Infant wide-field fundus photograph · image size 1240x1240
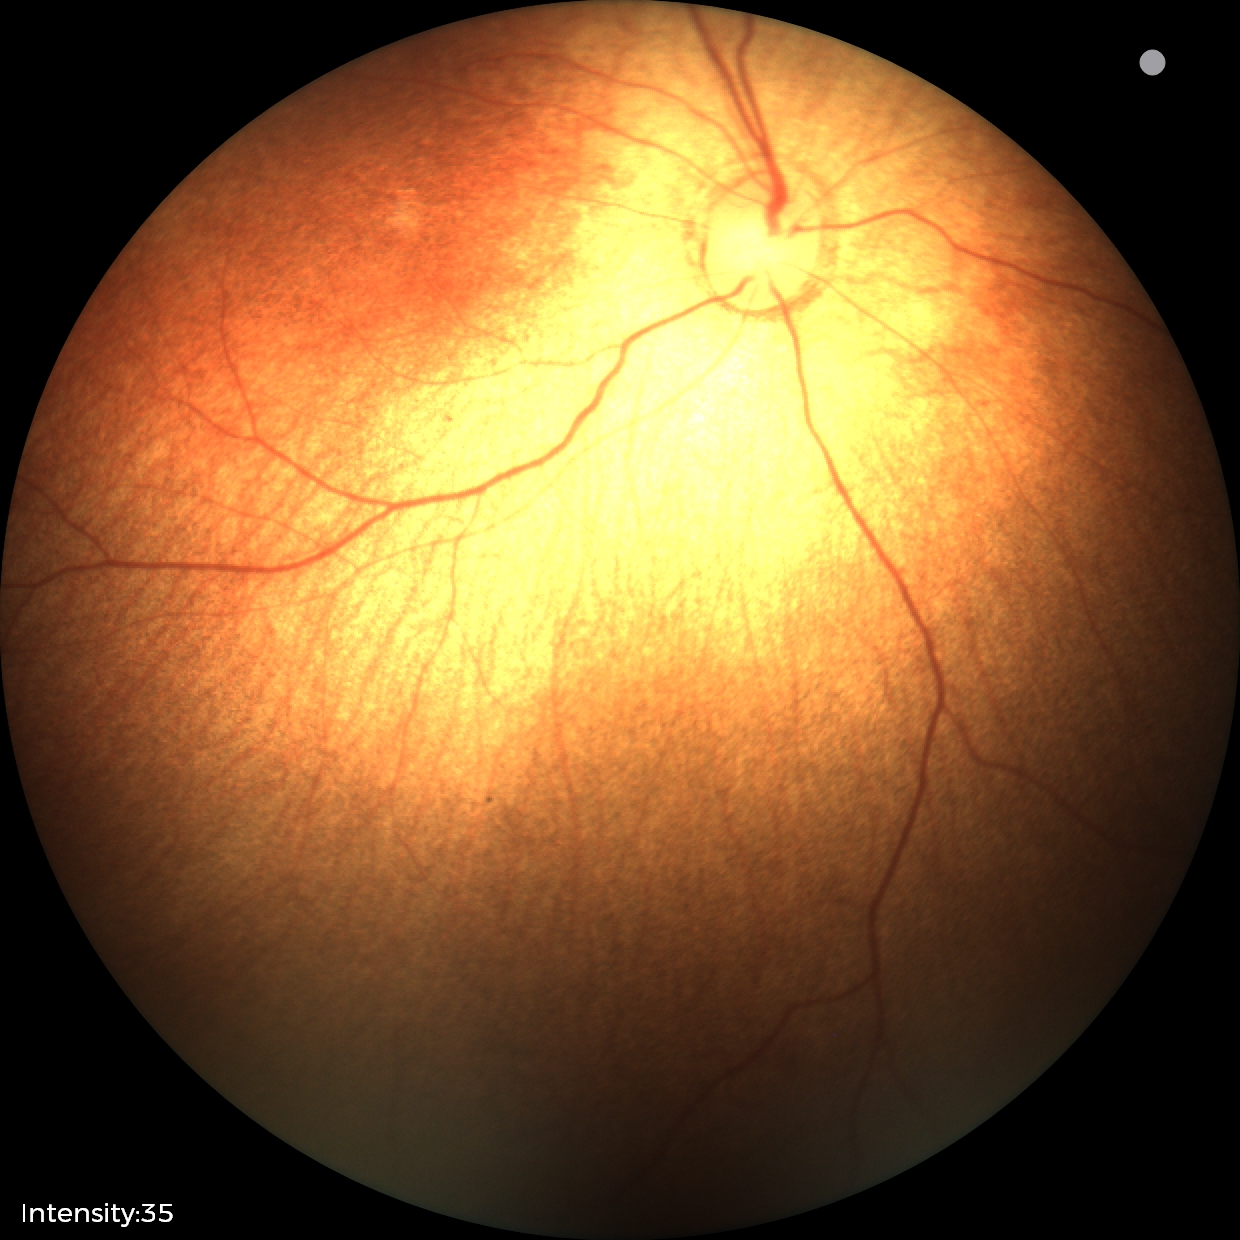

Normal screening examination.